Image size 640x480; infant wide-field retinal image:
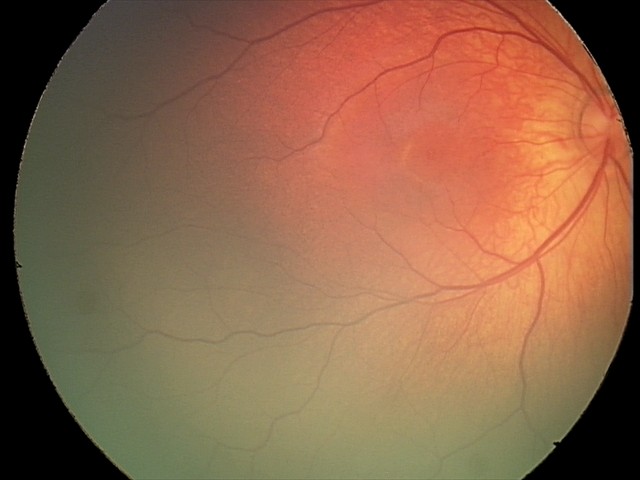 Physiological retinal appearance for postconceptual age.